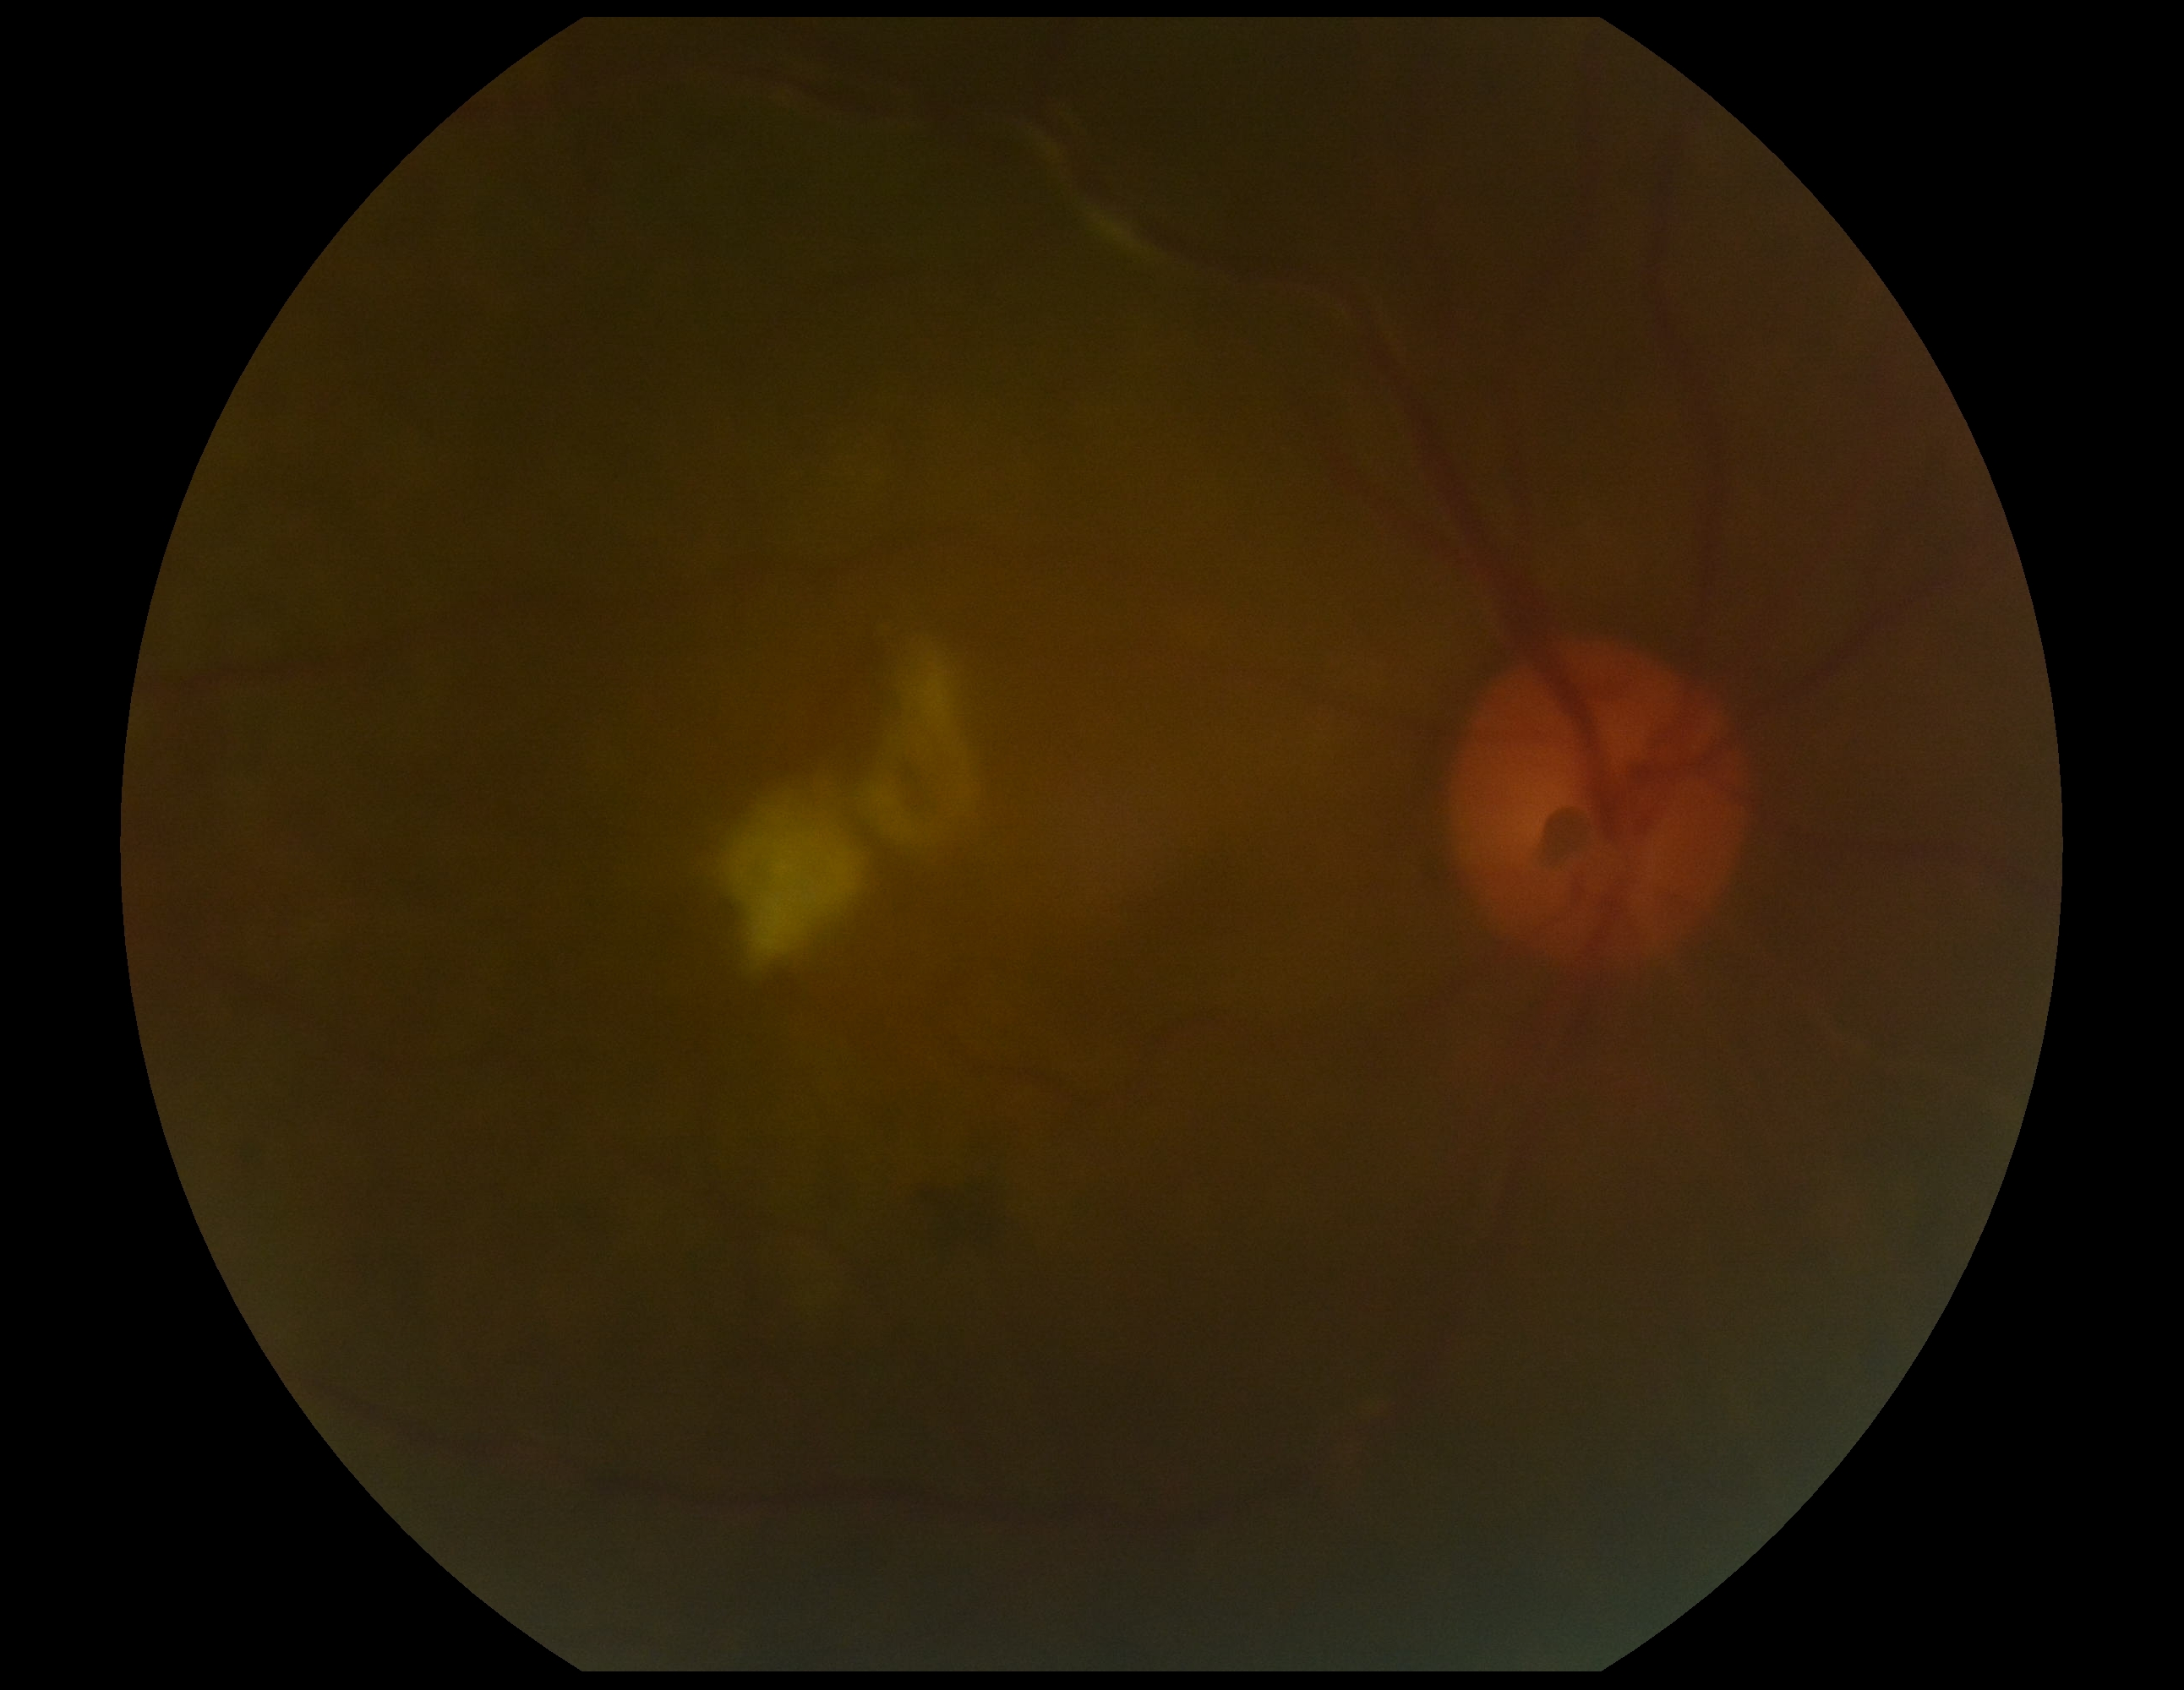
Annotations:
– DR stage: 2/4